NIDEK AFC-230 fundus camera:
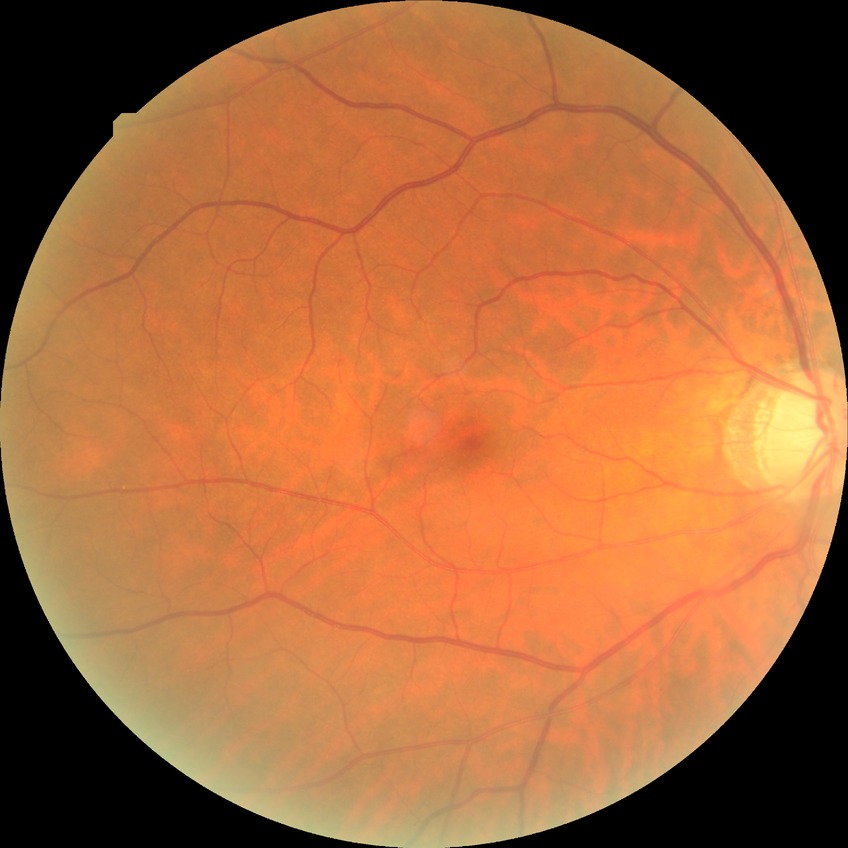 Diabetic retinopathy (DR) is no diabetic retinopathy (NDR).